Graded on the modified Davis scale
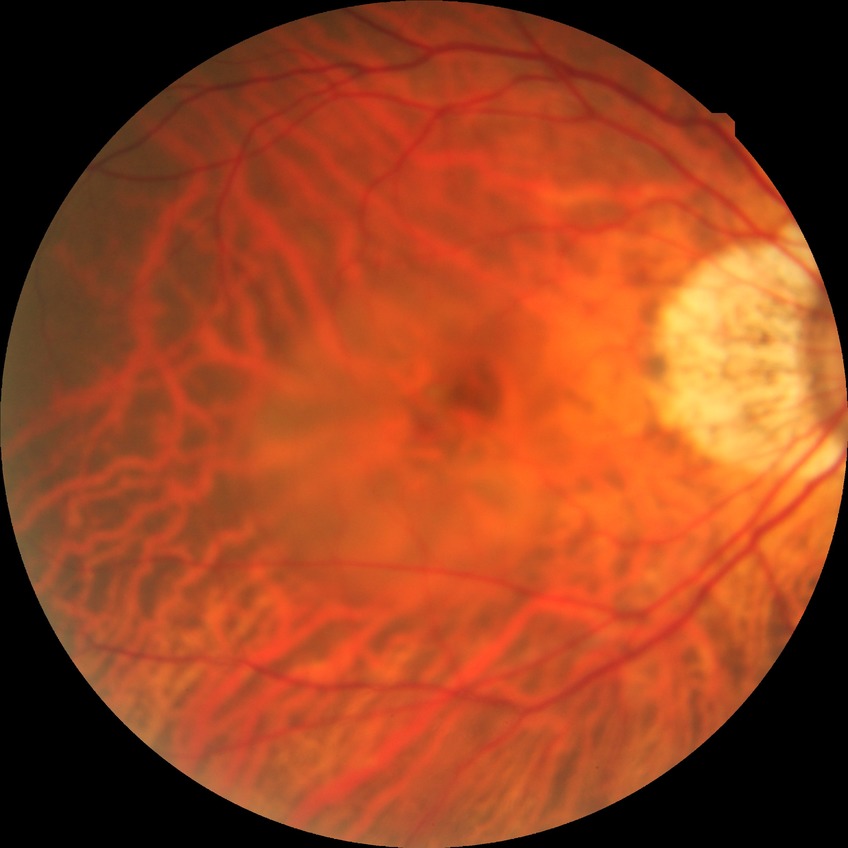
Retinopathy grade is no diabetic retinopathy.